Wide-field fundus photograph from neonatal ROP screening · acquired on the Clarity RetCam 3:
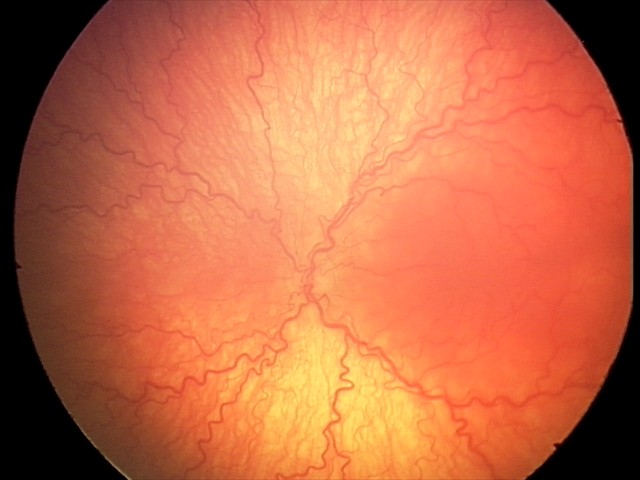

With plus disease.
Examination diagnosed as aggressive retinopathy of prematurity.